No pharmacologic dilation; 848x848; CFP; FOV: 45 degrees — 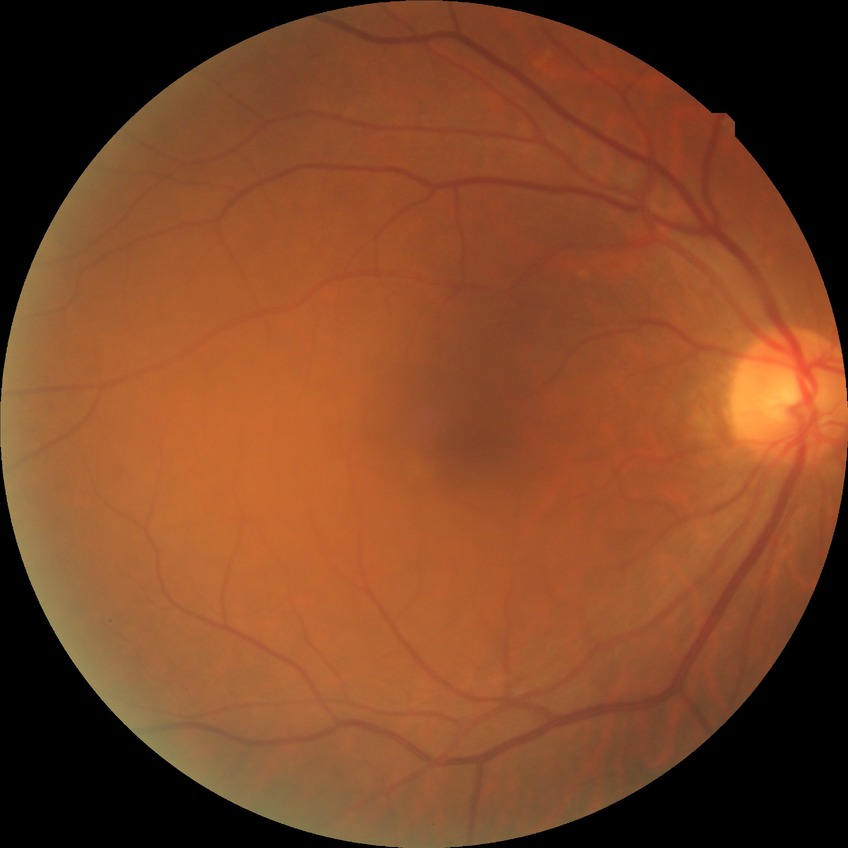
diabetic retinopathy (DR)@NDR (no diabetic retinopathy).